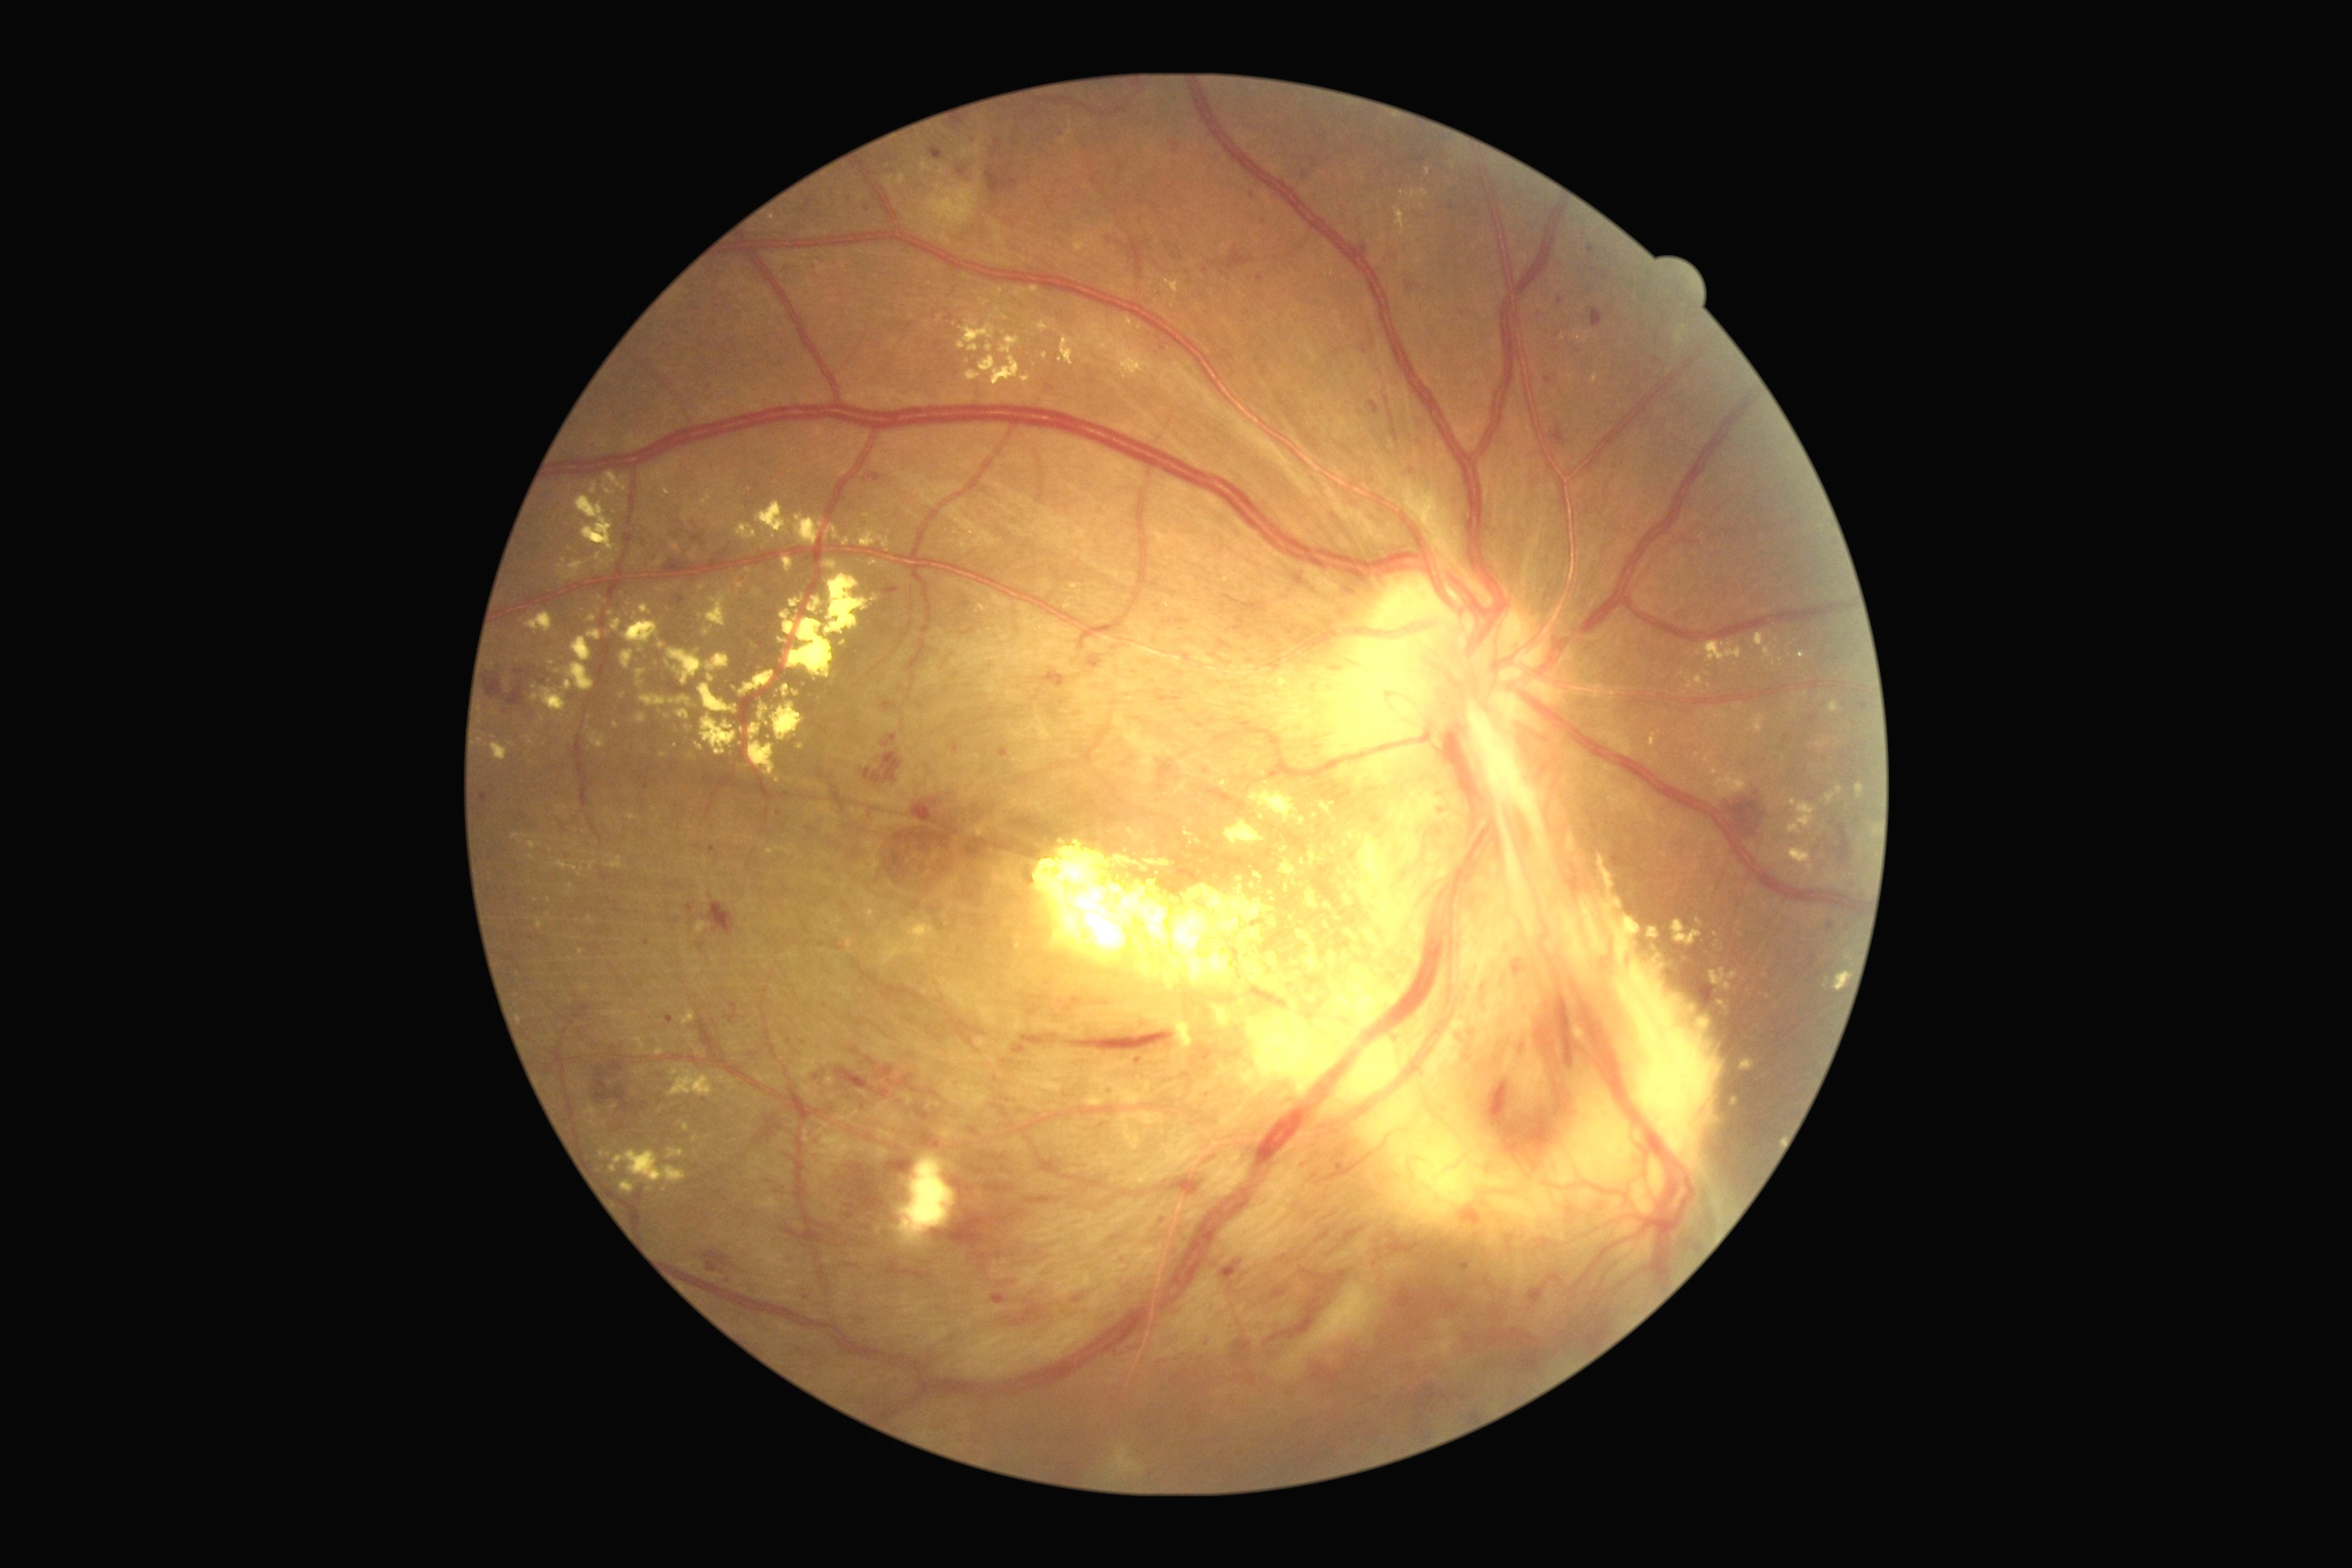

Diabetic retinopathy (DR): 4 — neovascularization and/or vitreous/pre-retinal hemorrhage; proliferative diabetic retinopathy.
Hard exudates (EXs) (partial list) at 1220:781:1230:789 | 1184:828:1202:847 | 756:502:792:540 | 1268:917:1277:928 | 966:369:981:382 | 676:710:691:720 | 1297:930:1311:941 | 589:861:596:872 | 533:687:567:712 | 1137:963:1231:992 | 605:473:629:491 | 607:856:623:870 | 625:600:631:609.
Smaller EXs around 992/318 | 1287/888 | 758/702 | 661/590 | 1253/887 | 534/689.